Davis DR grading
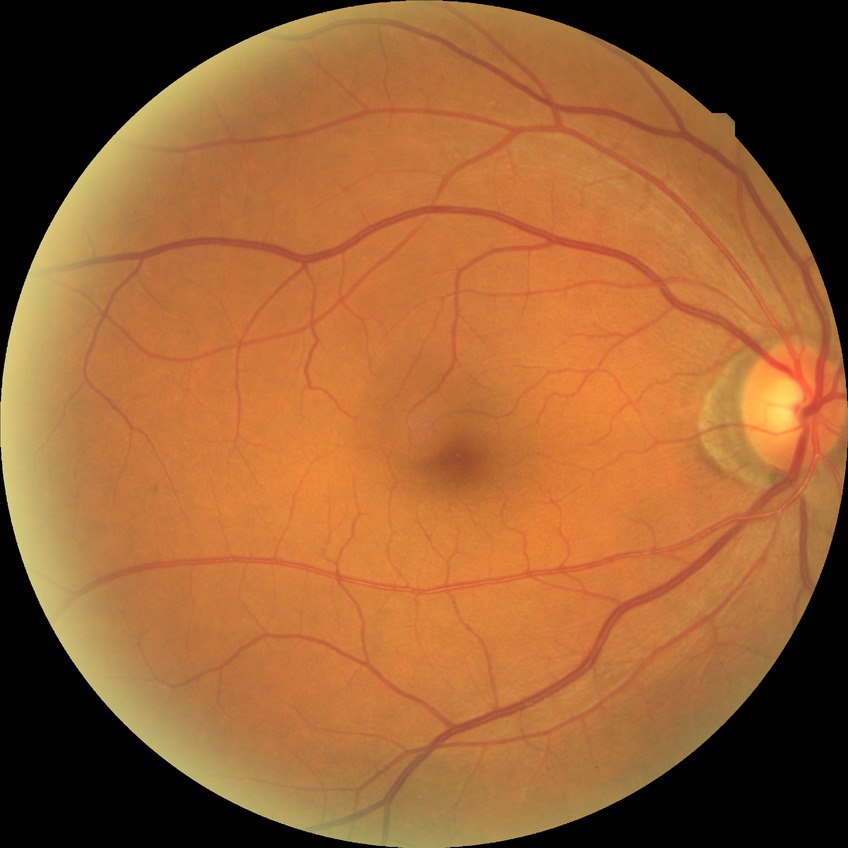
modified Davis grading = no diabetic retinopathy.